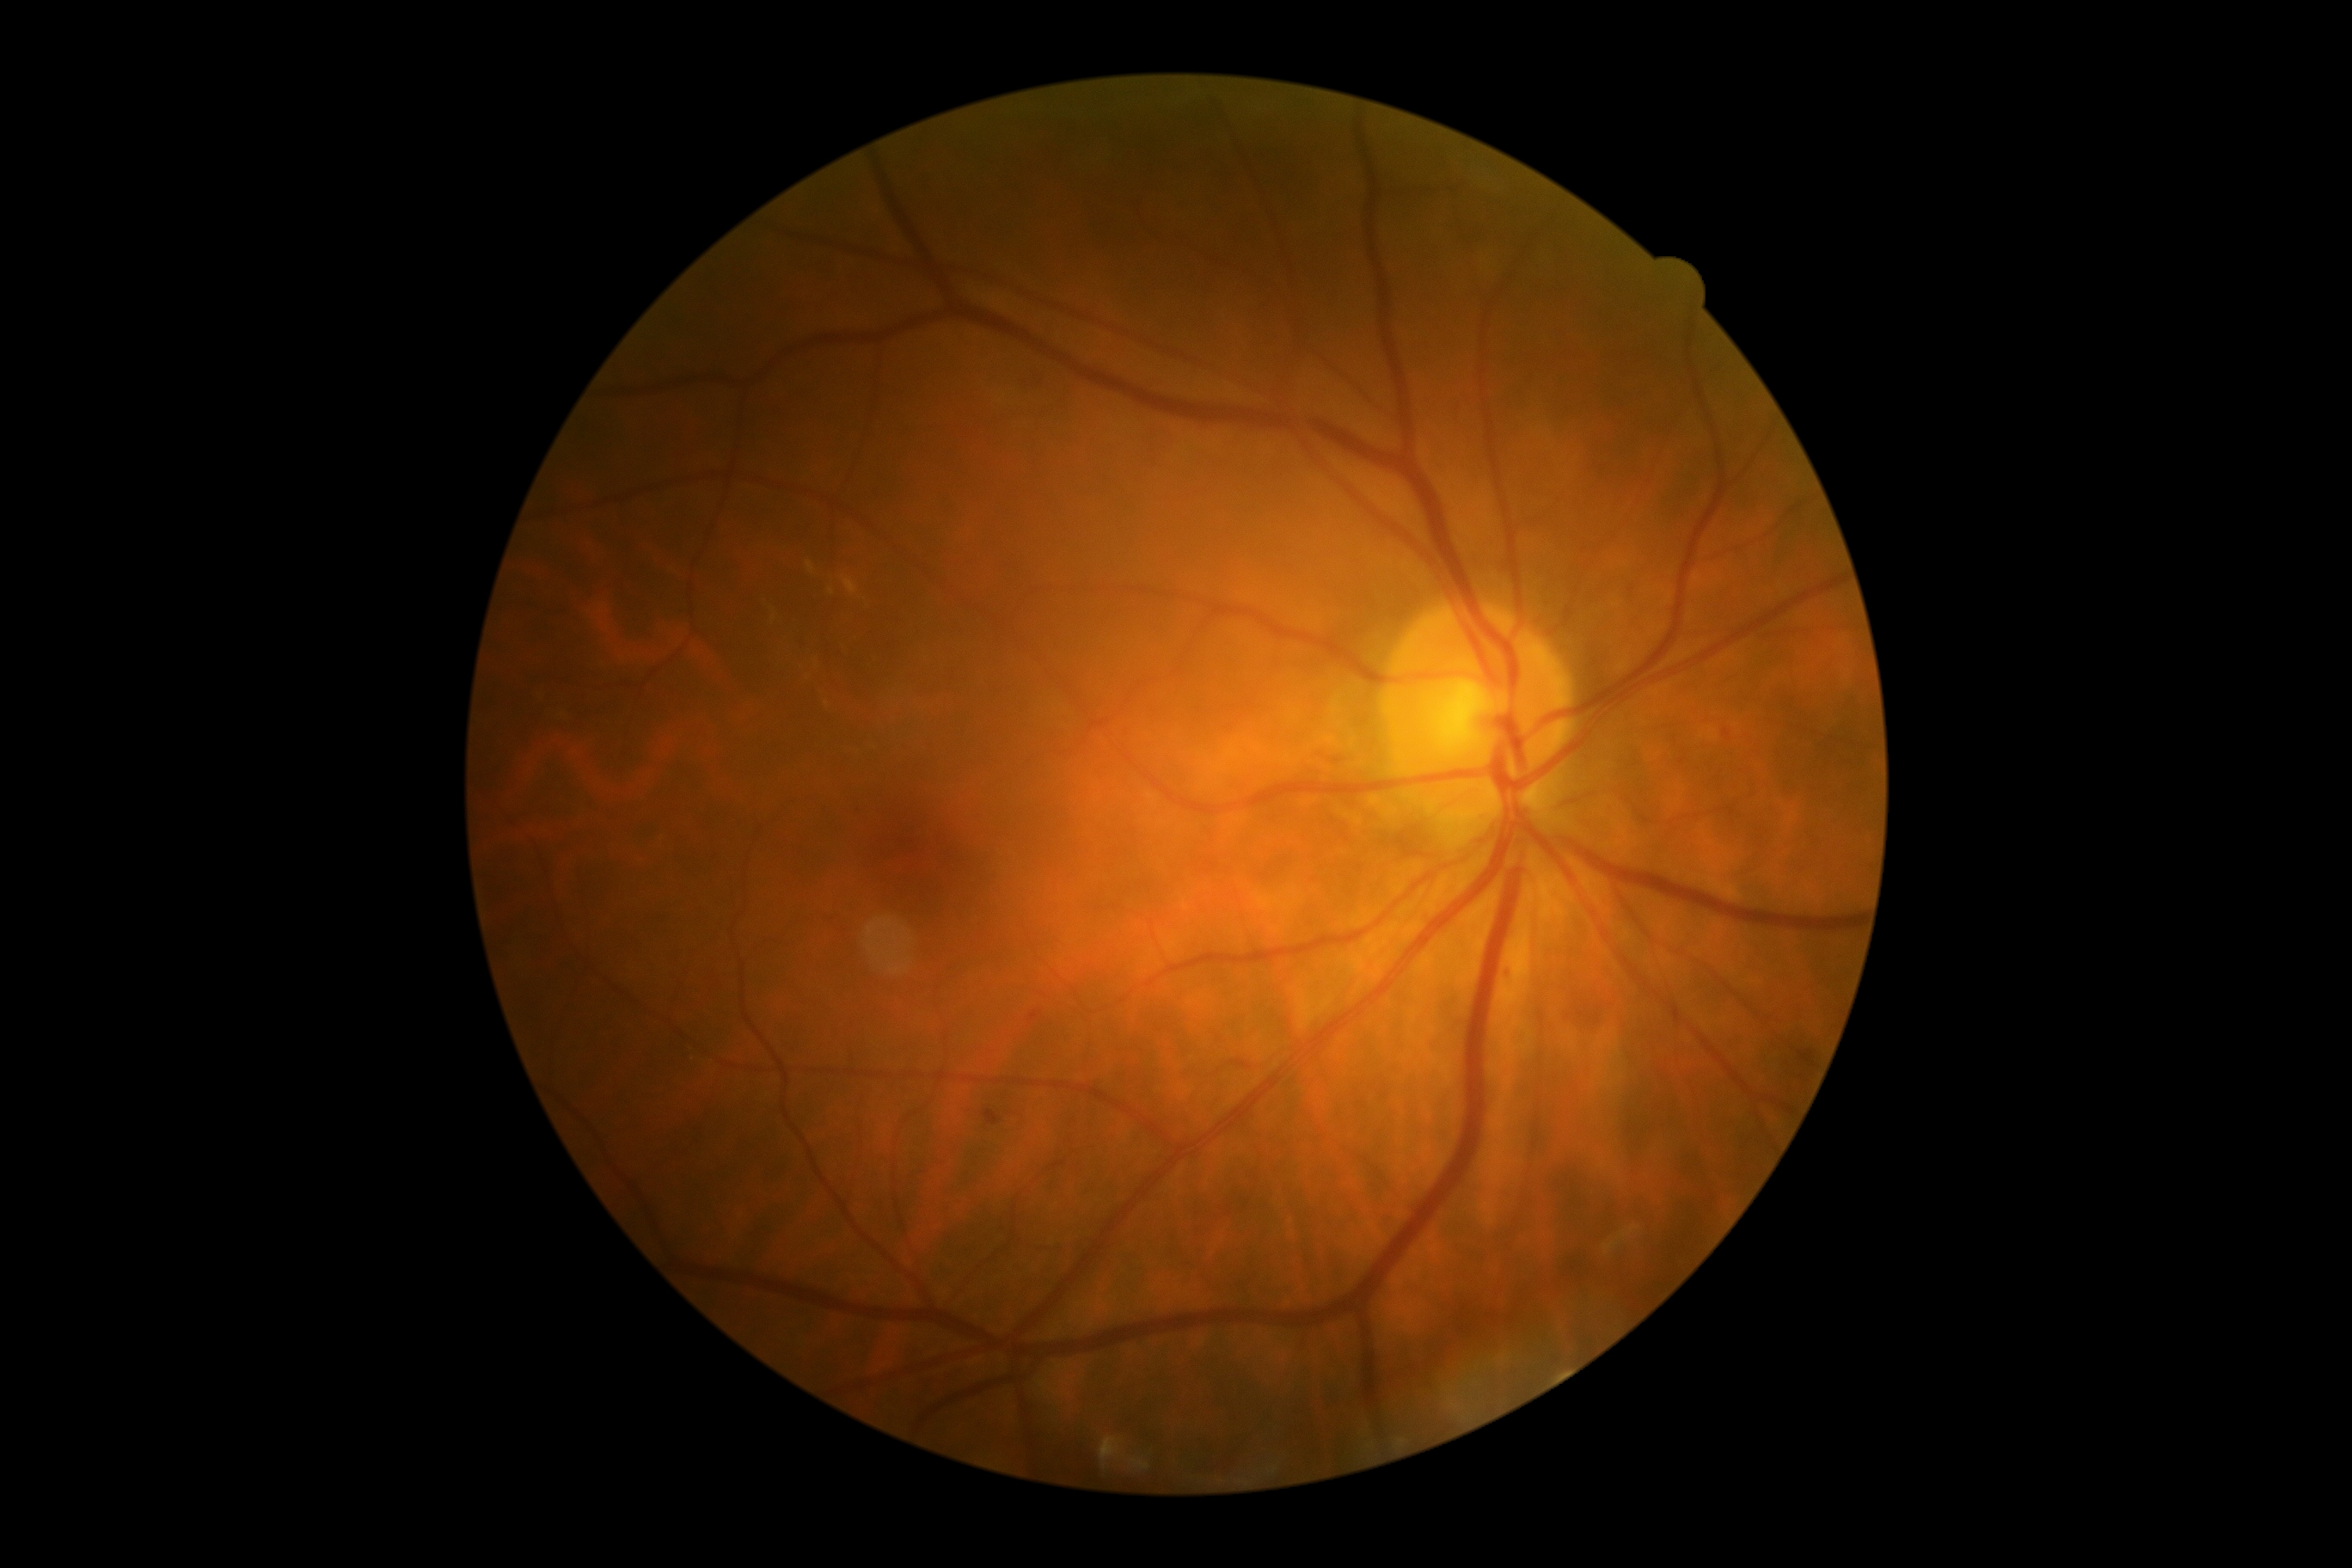 DR grade is 2. DR class: non-proliferative diabetic retinopathy.